Intraocular pressure 18 mmHg by non-contact tonometry; 58-year-old patient — 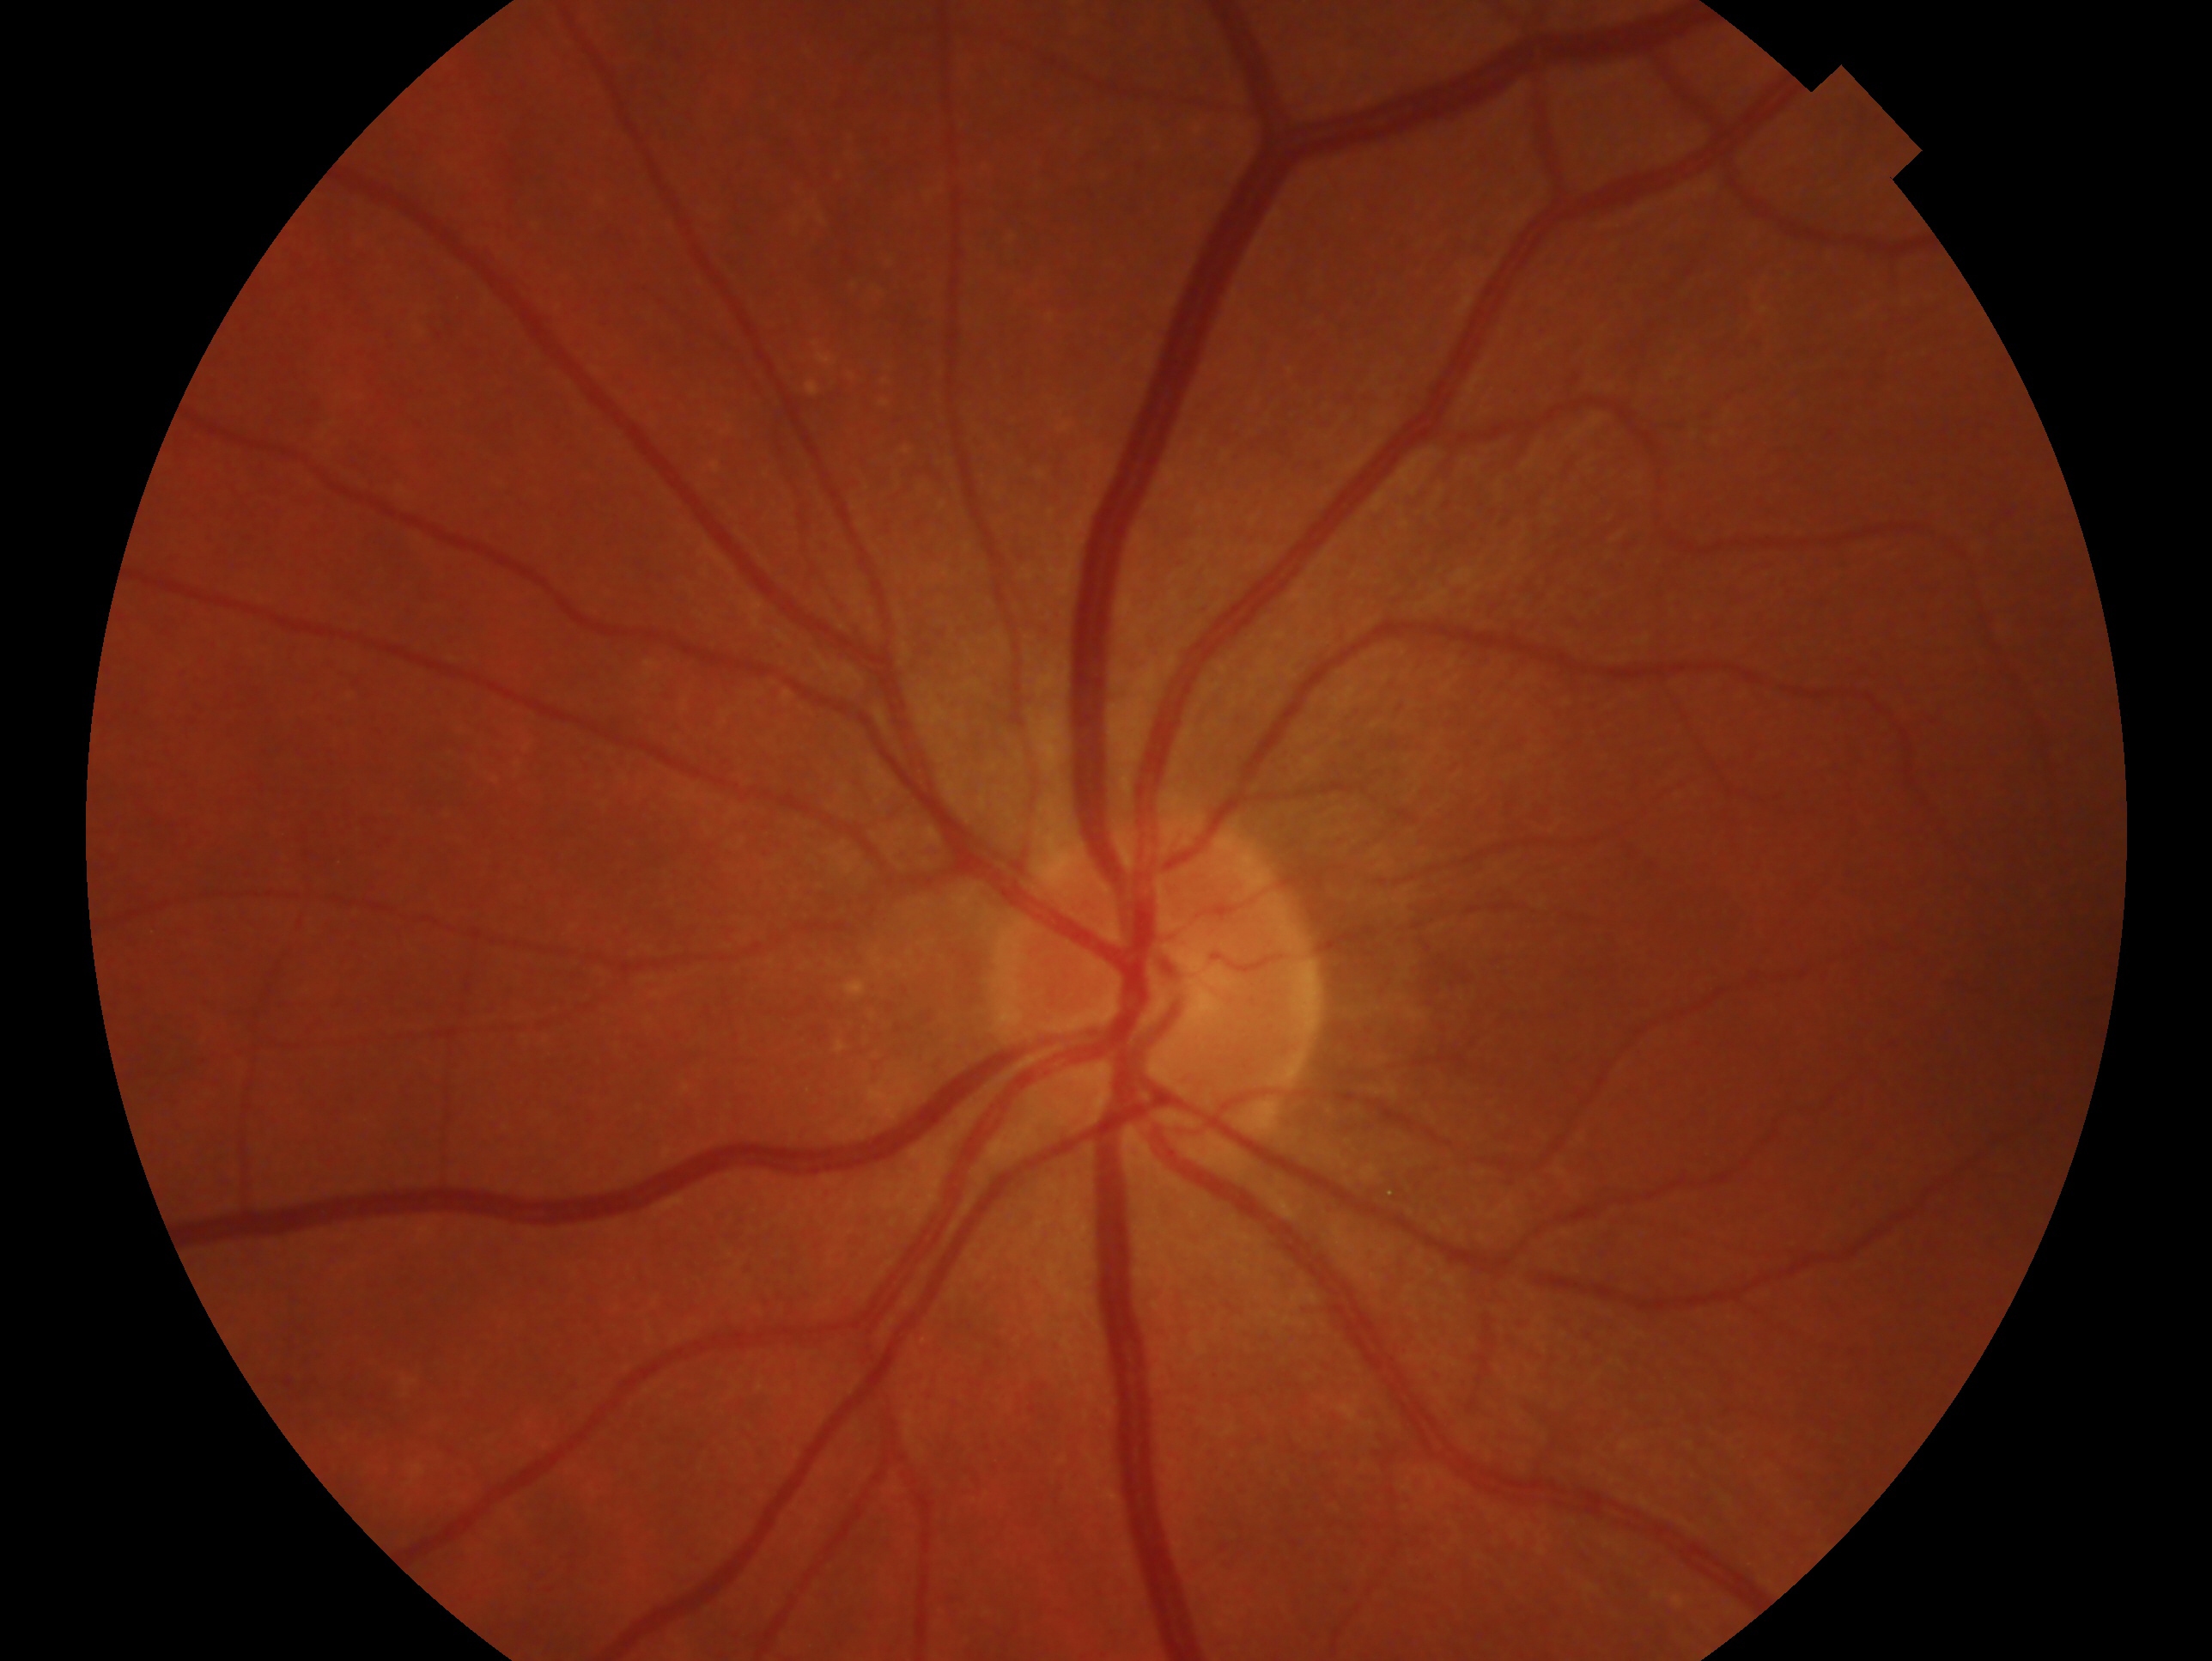 Imaged eye: left. Glaucoma assessment: no evidence of glaucoma — no clinical evidence of glaucoma in this eye.